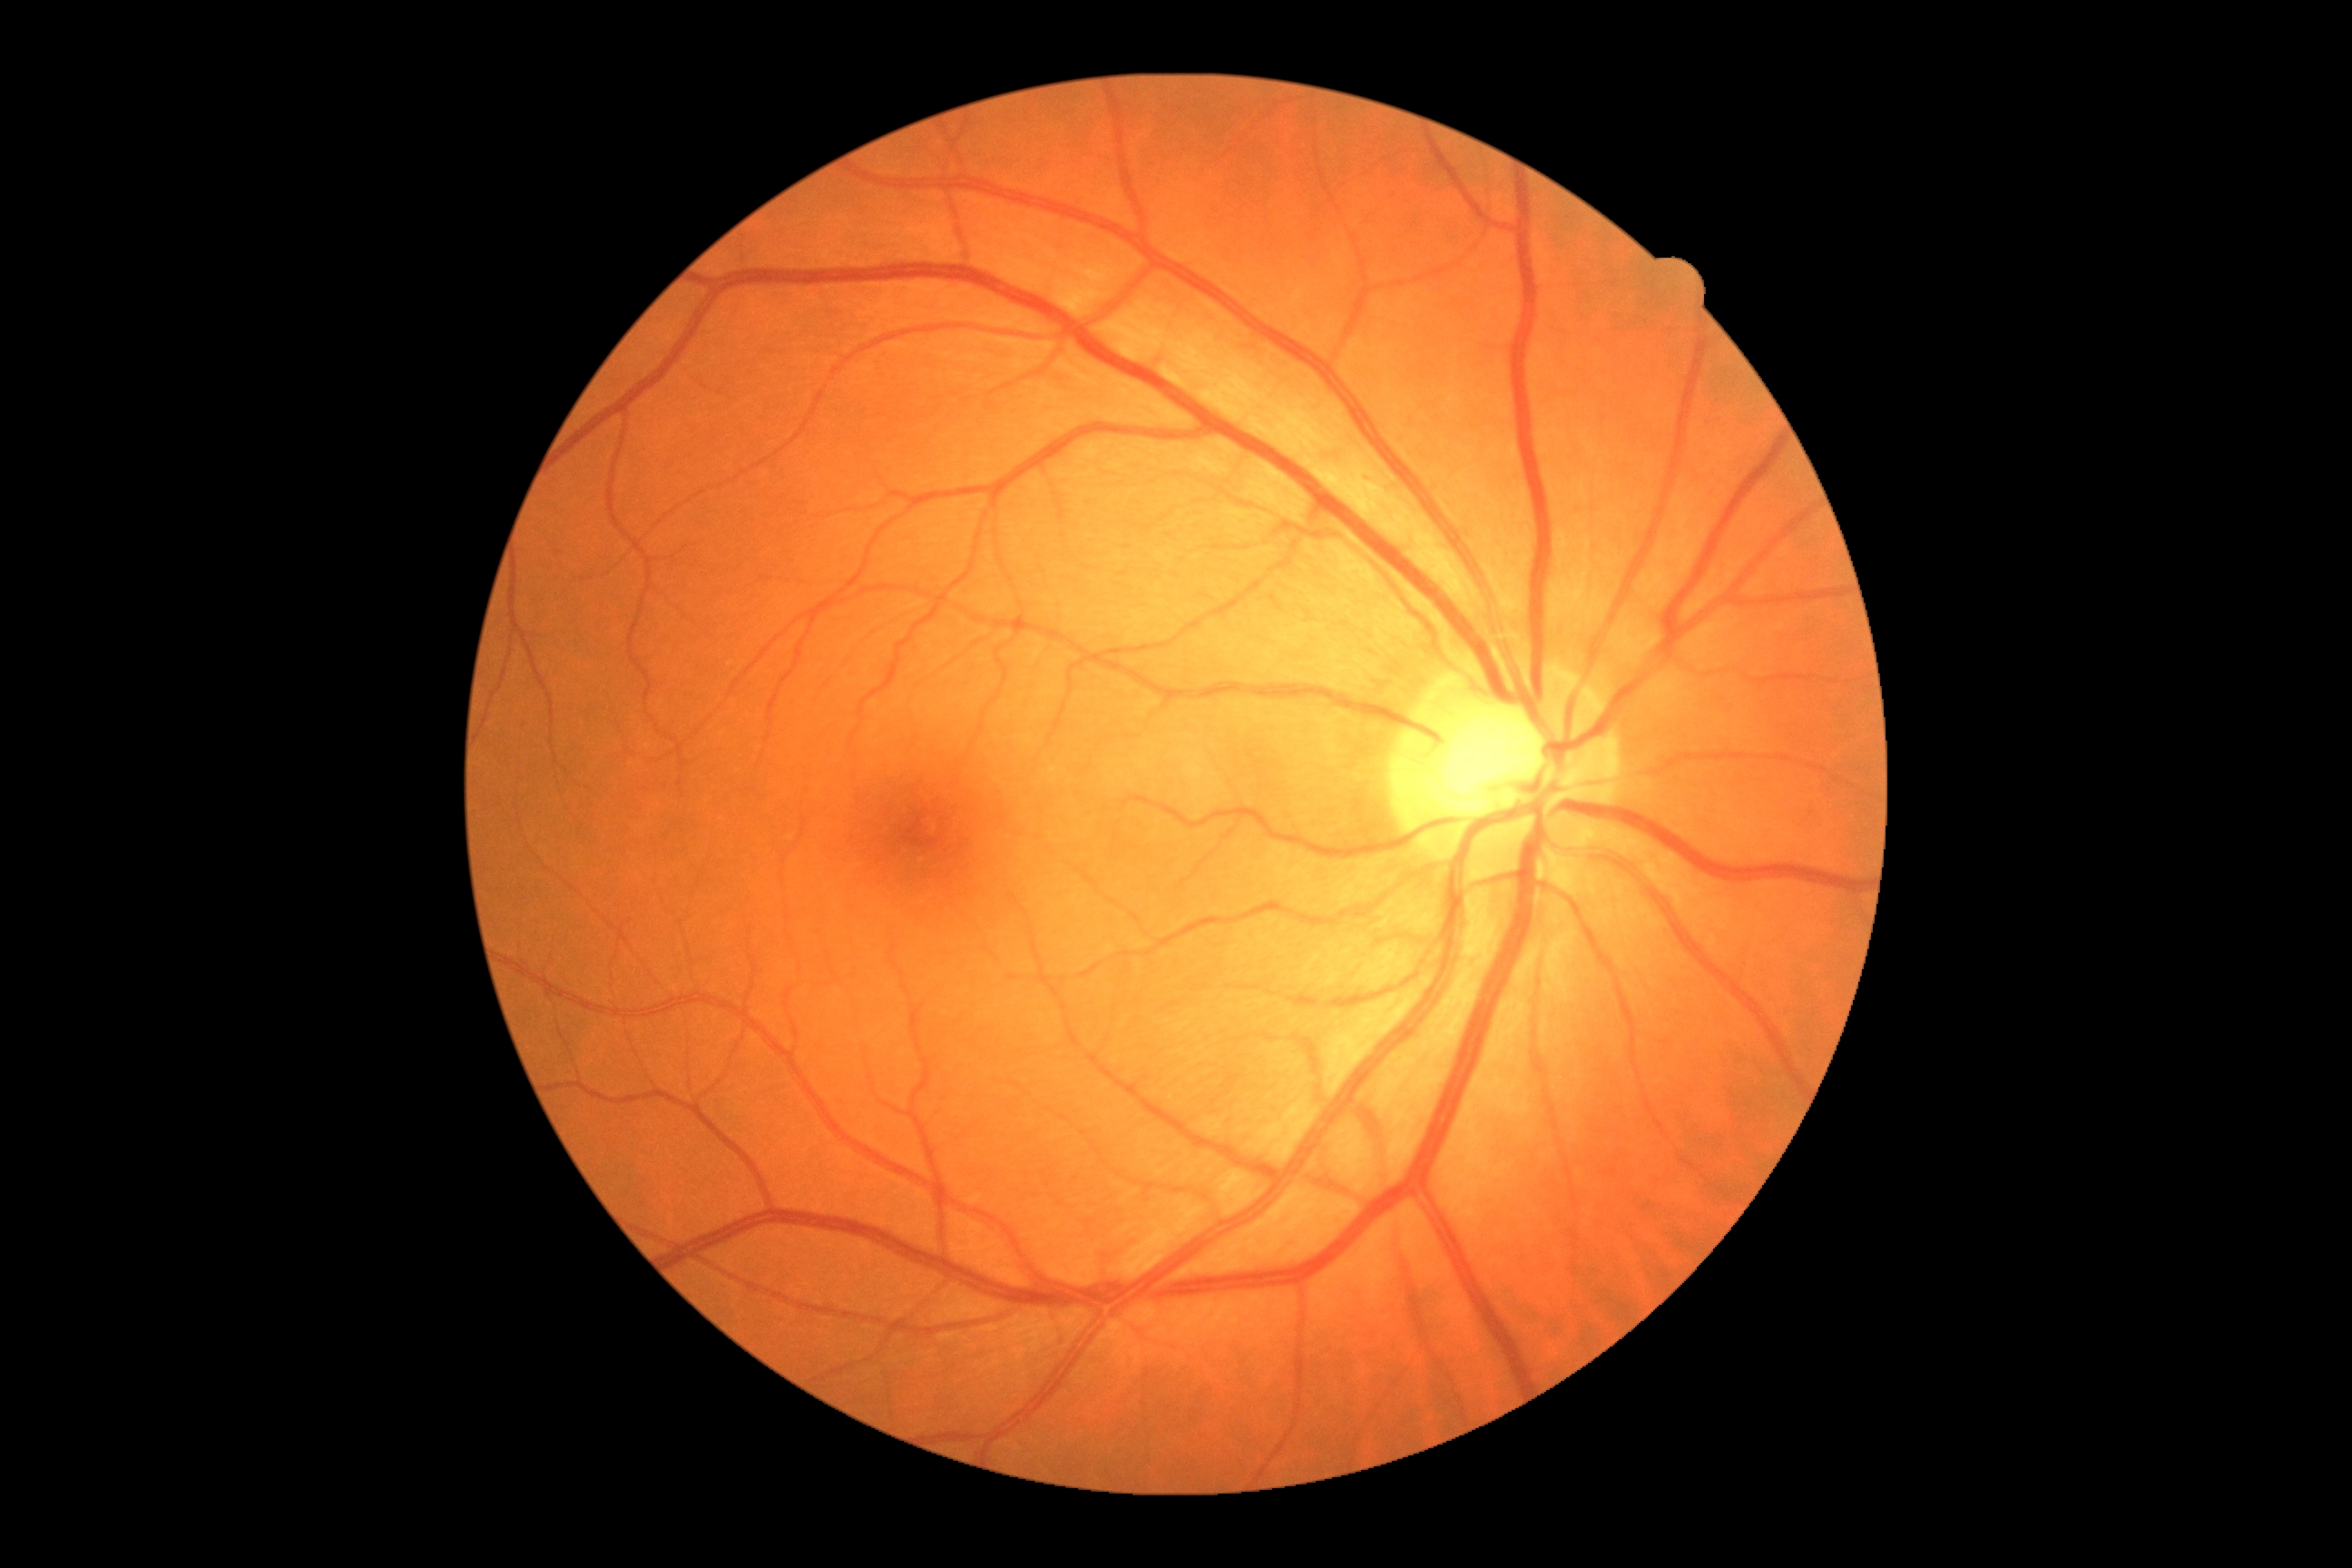
DR stage=no apparent retinopathy (grade 0) — no visible signs of diabetic retinopathy.